Ultra-widefield fundus photograph · 1924x1556 — 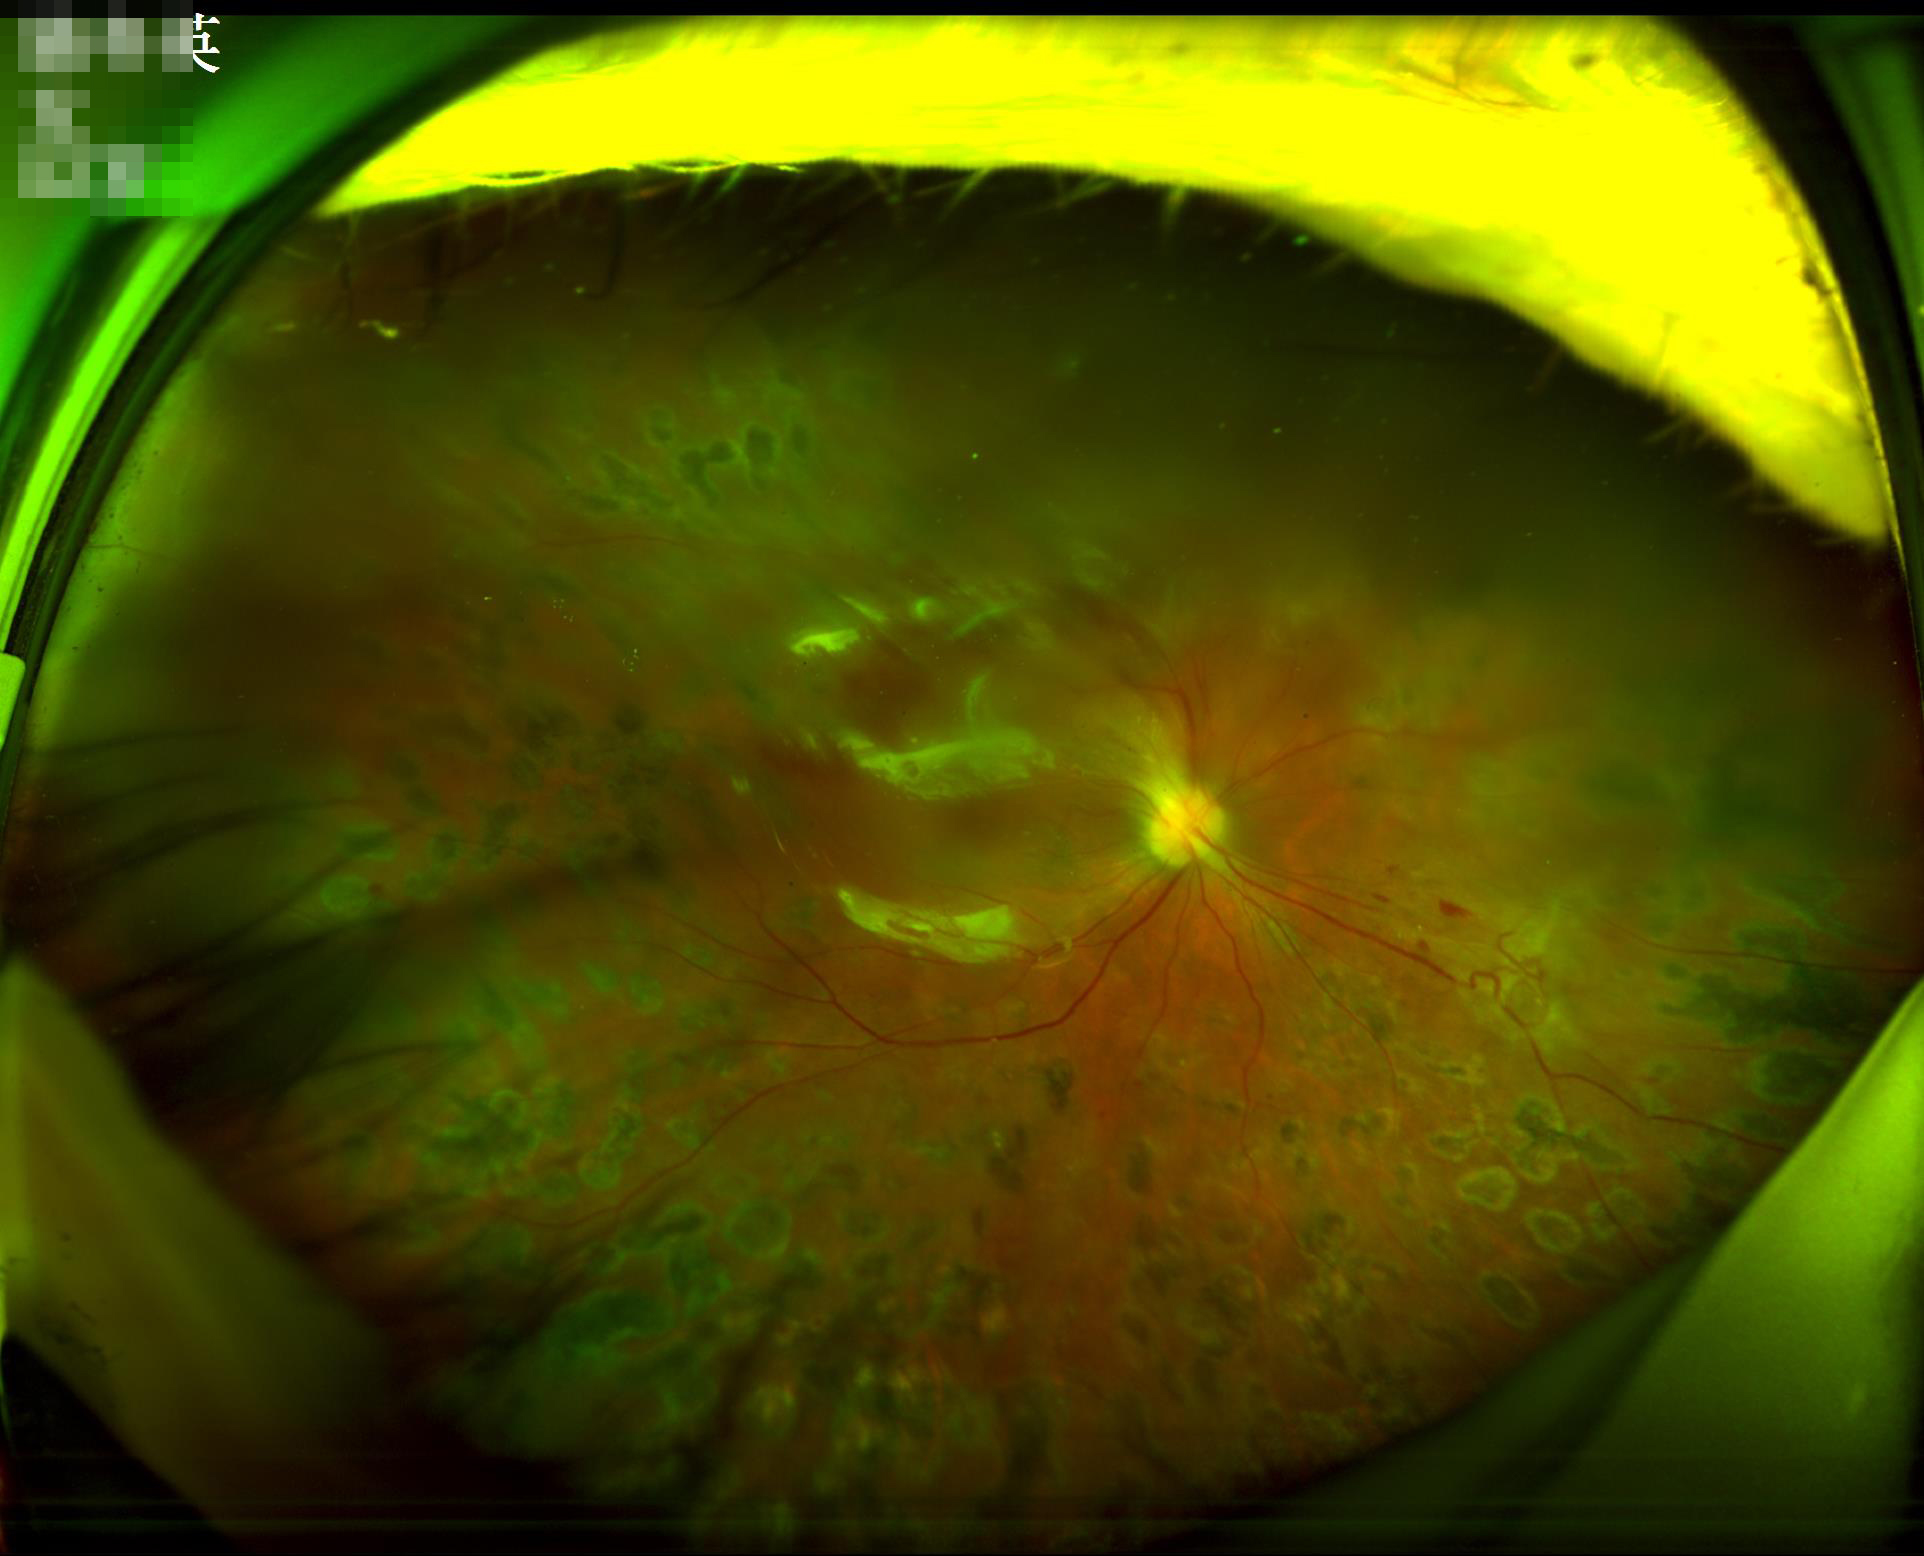
Out of focus; structures are indistinct. Contrast is good. Poor illumination with uneven exposure. Image quality is inadequate for diagnostic use.